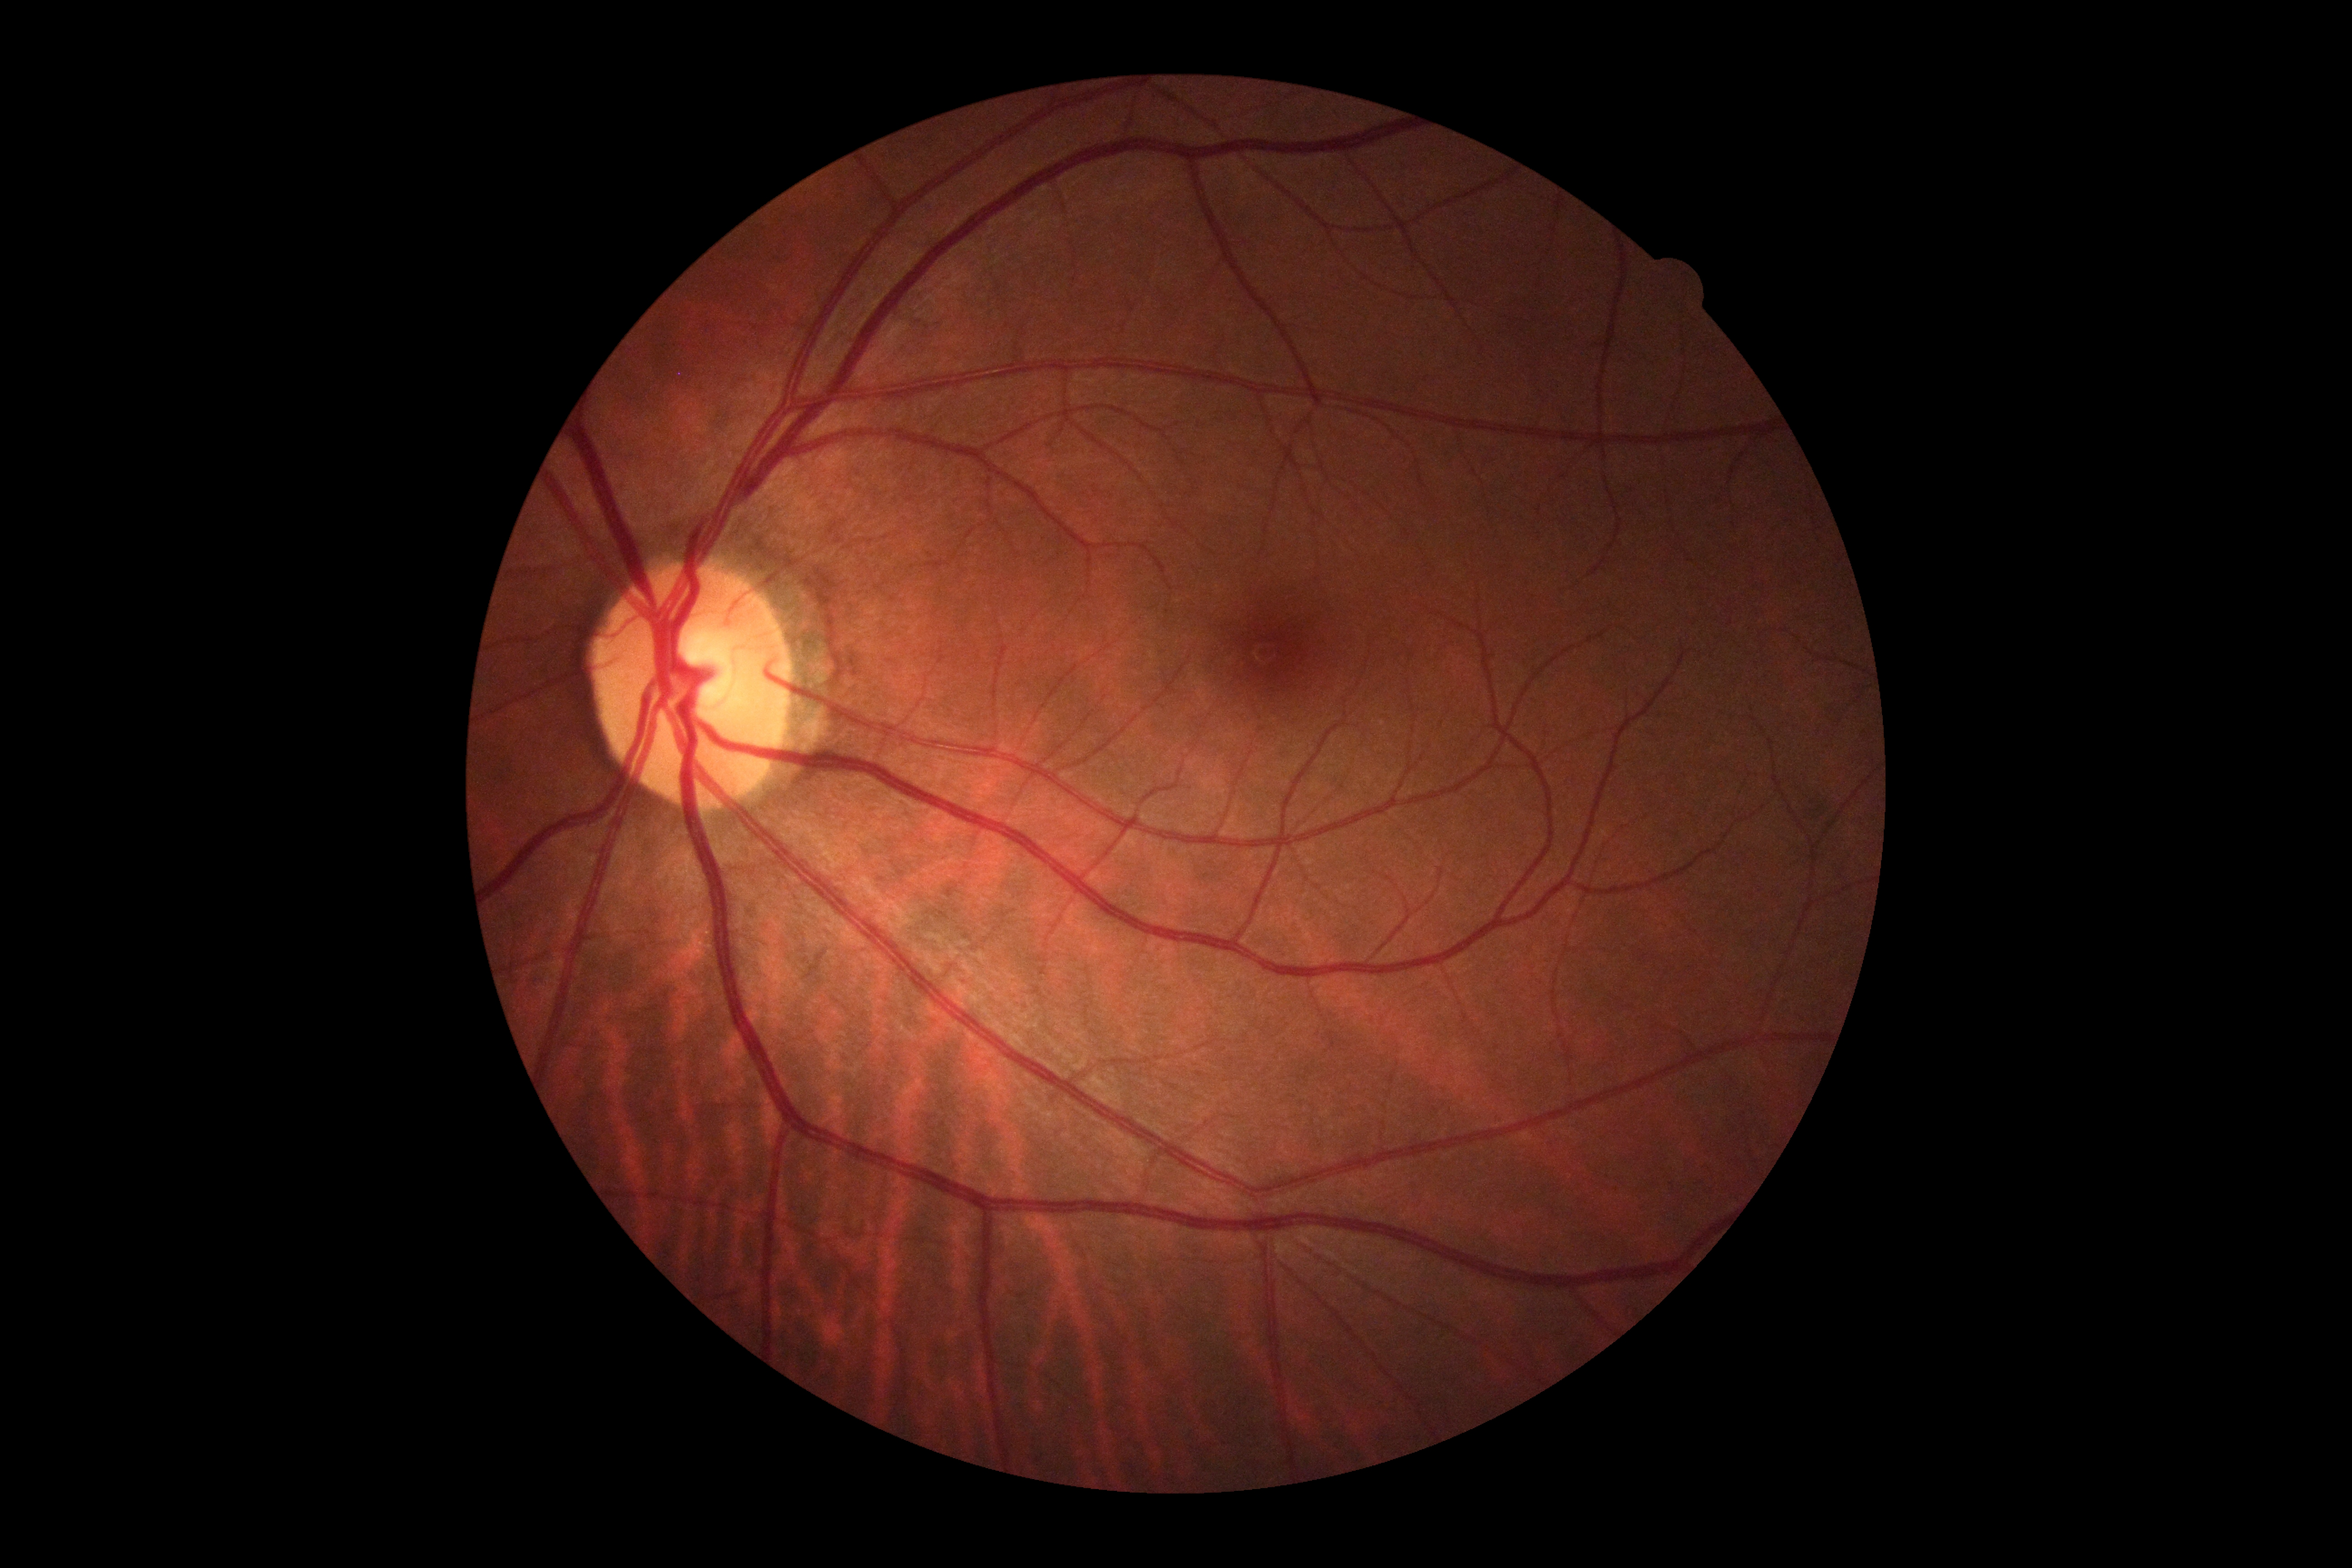
Diabetic retinopathy grade: 0/4.